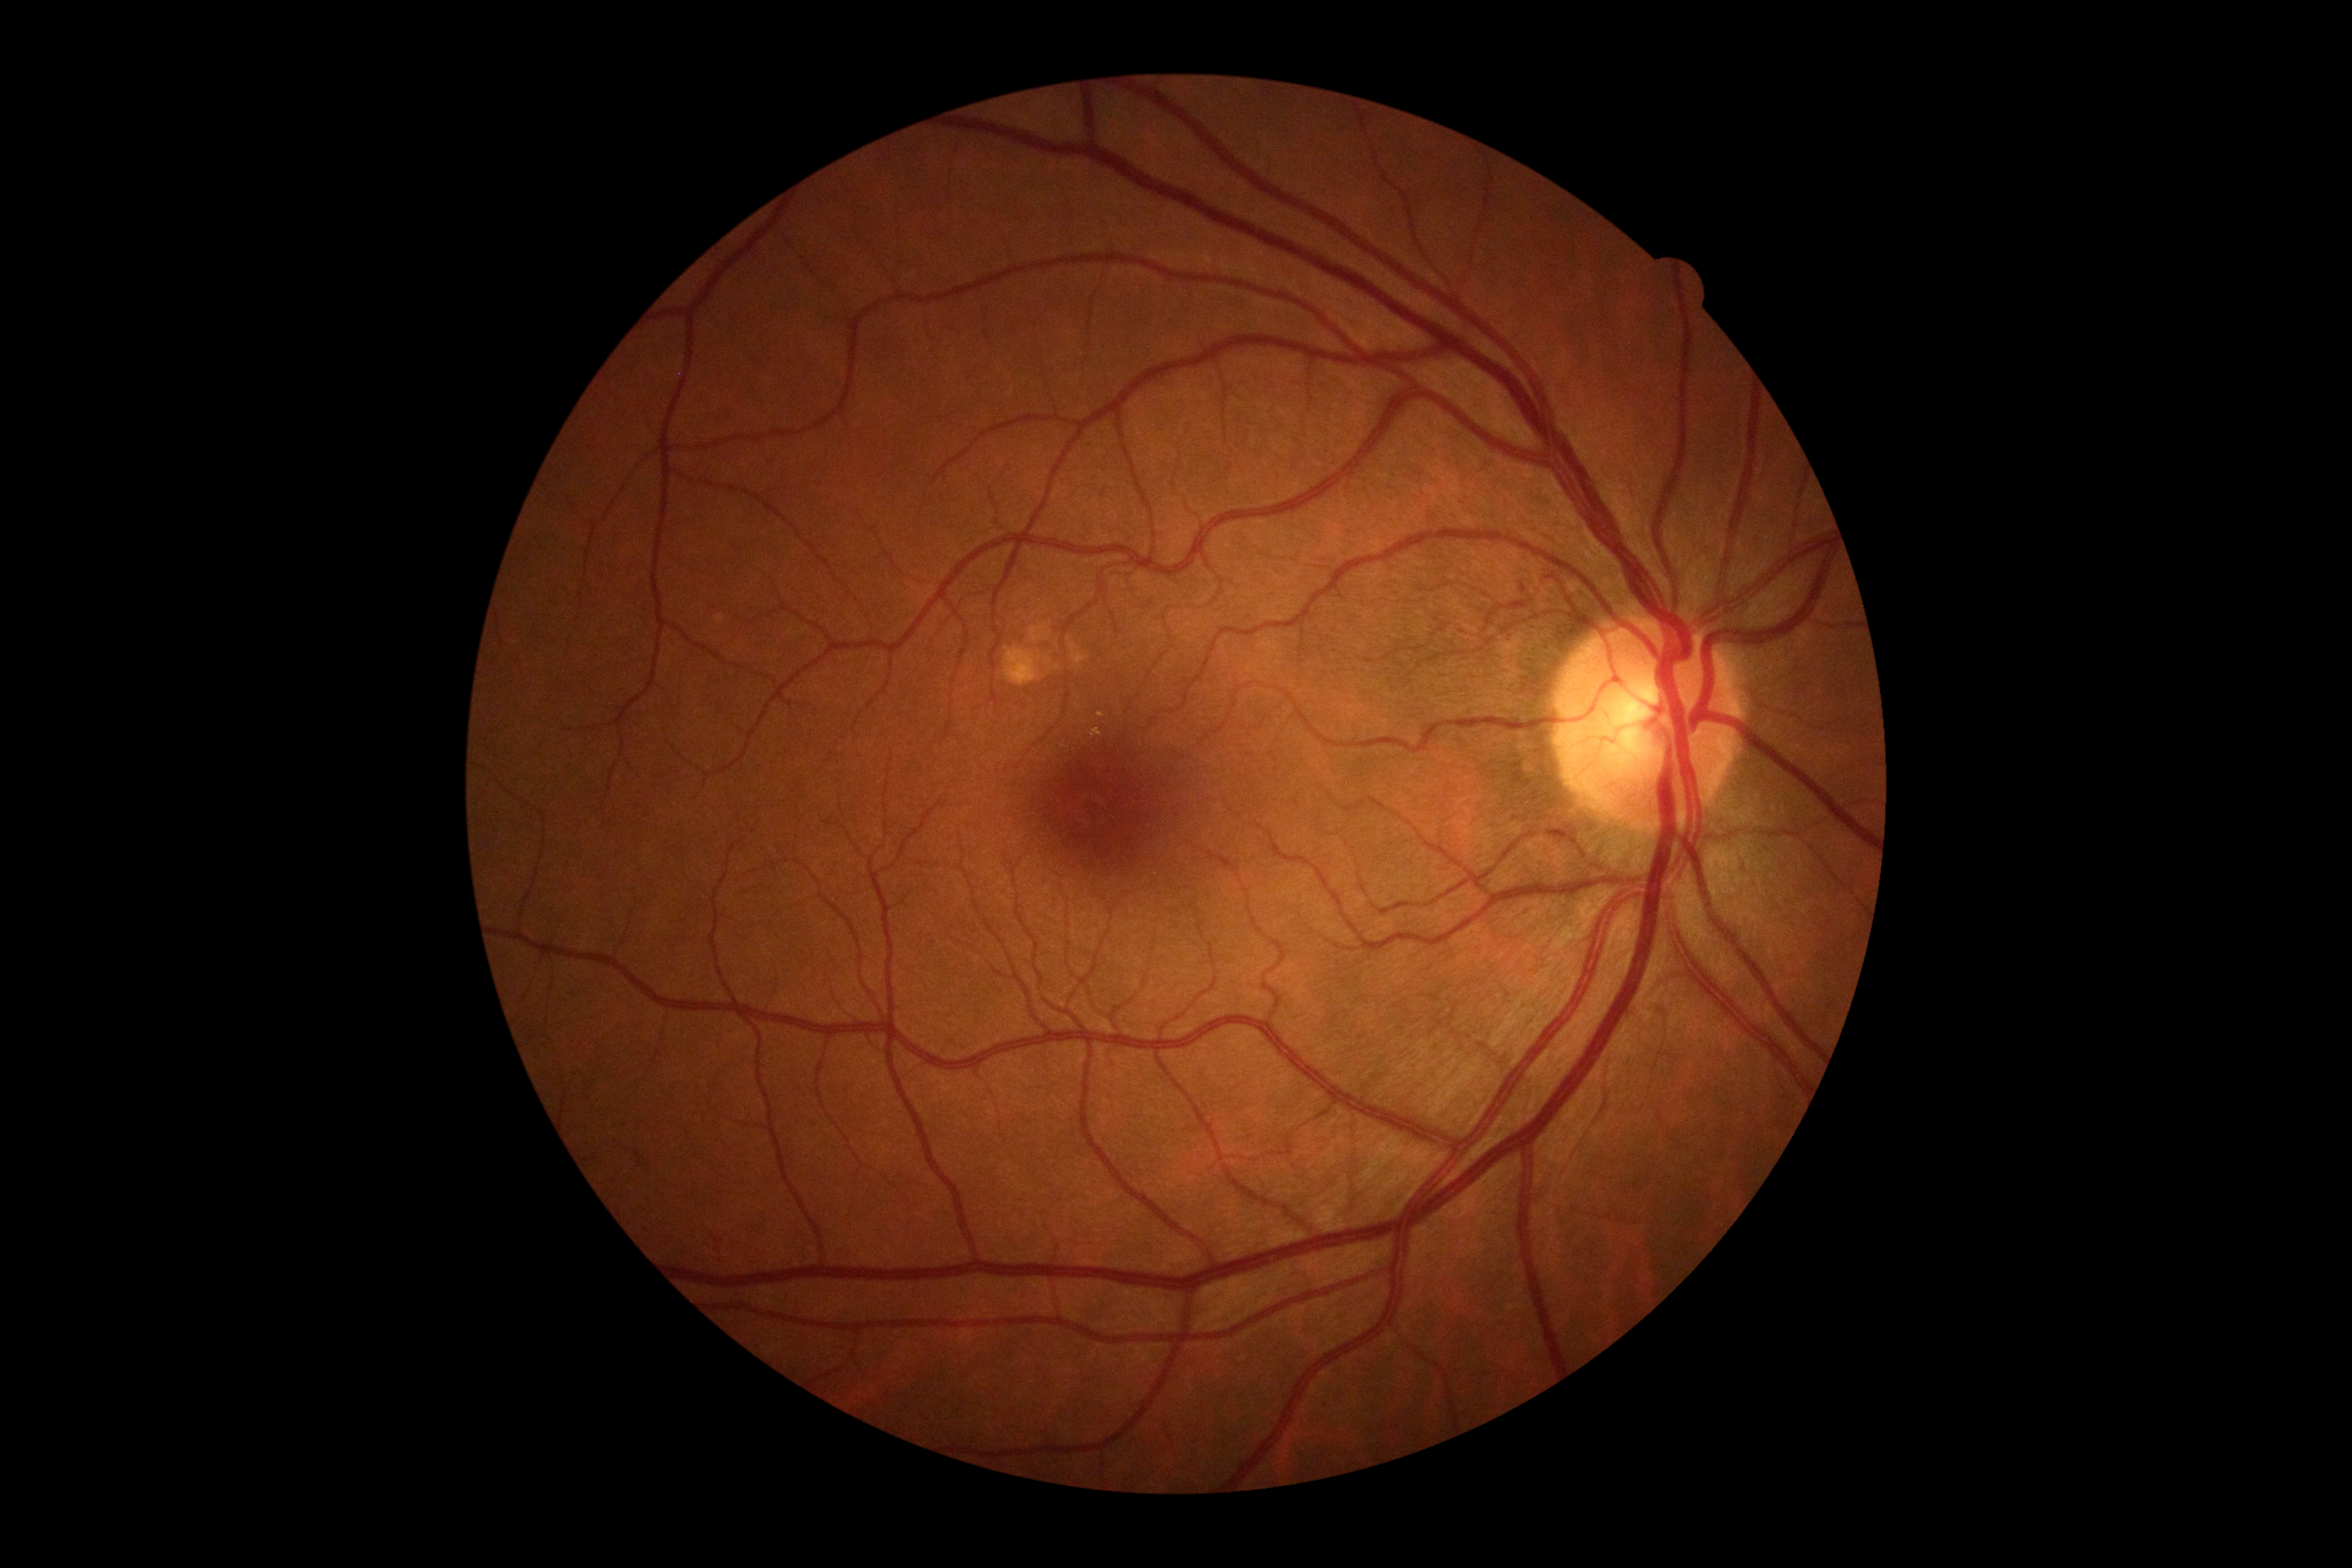 DR severity is 0. No signs of diabetic retinopathy.